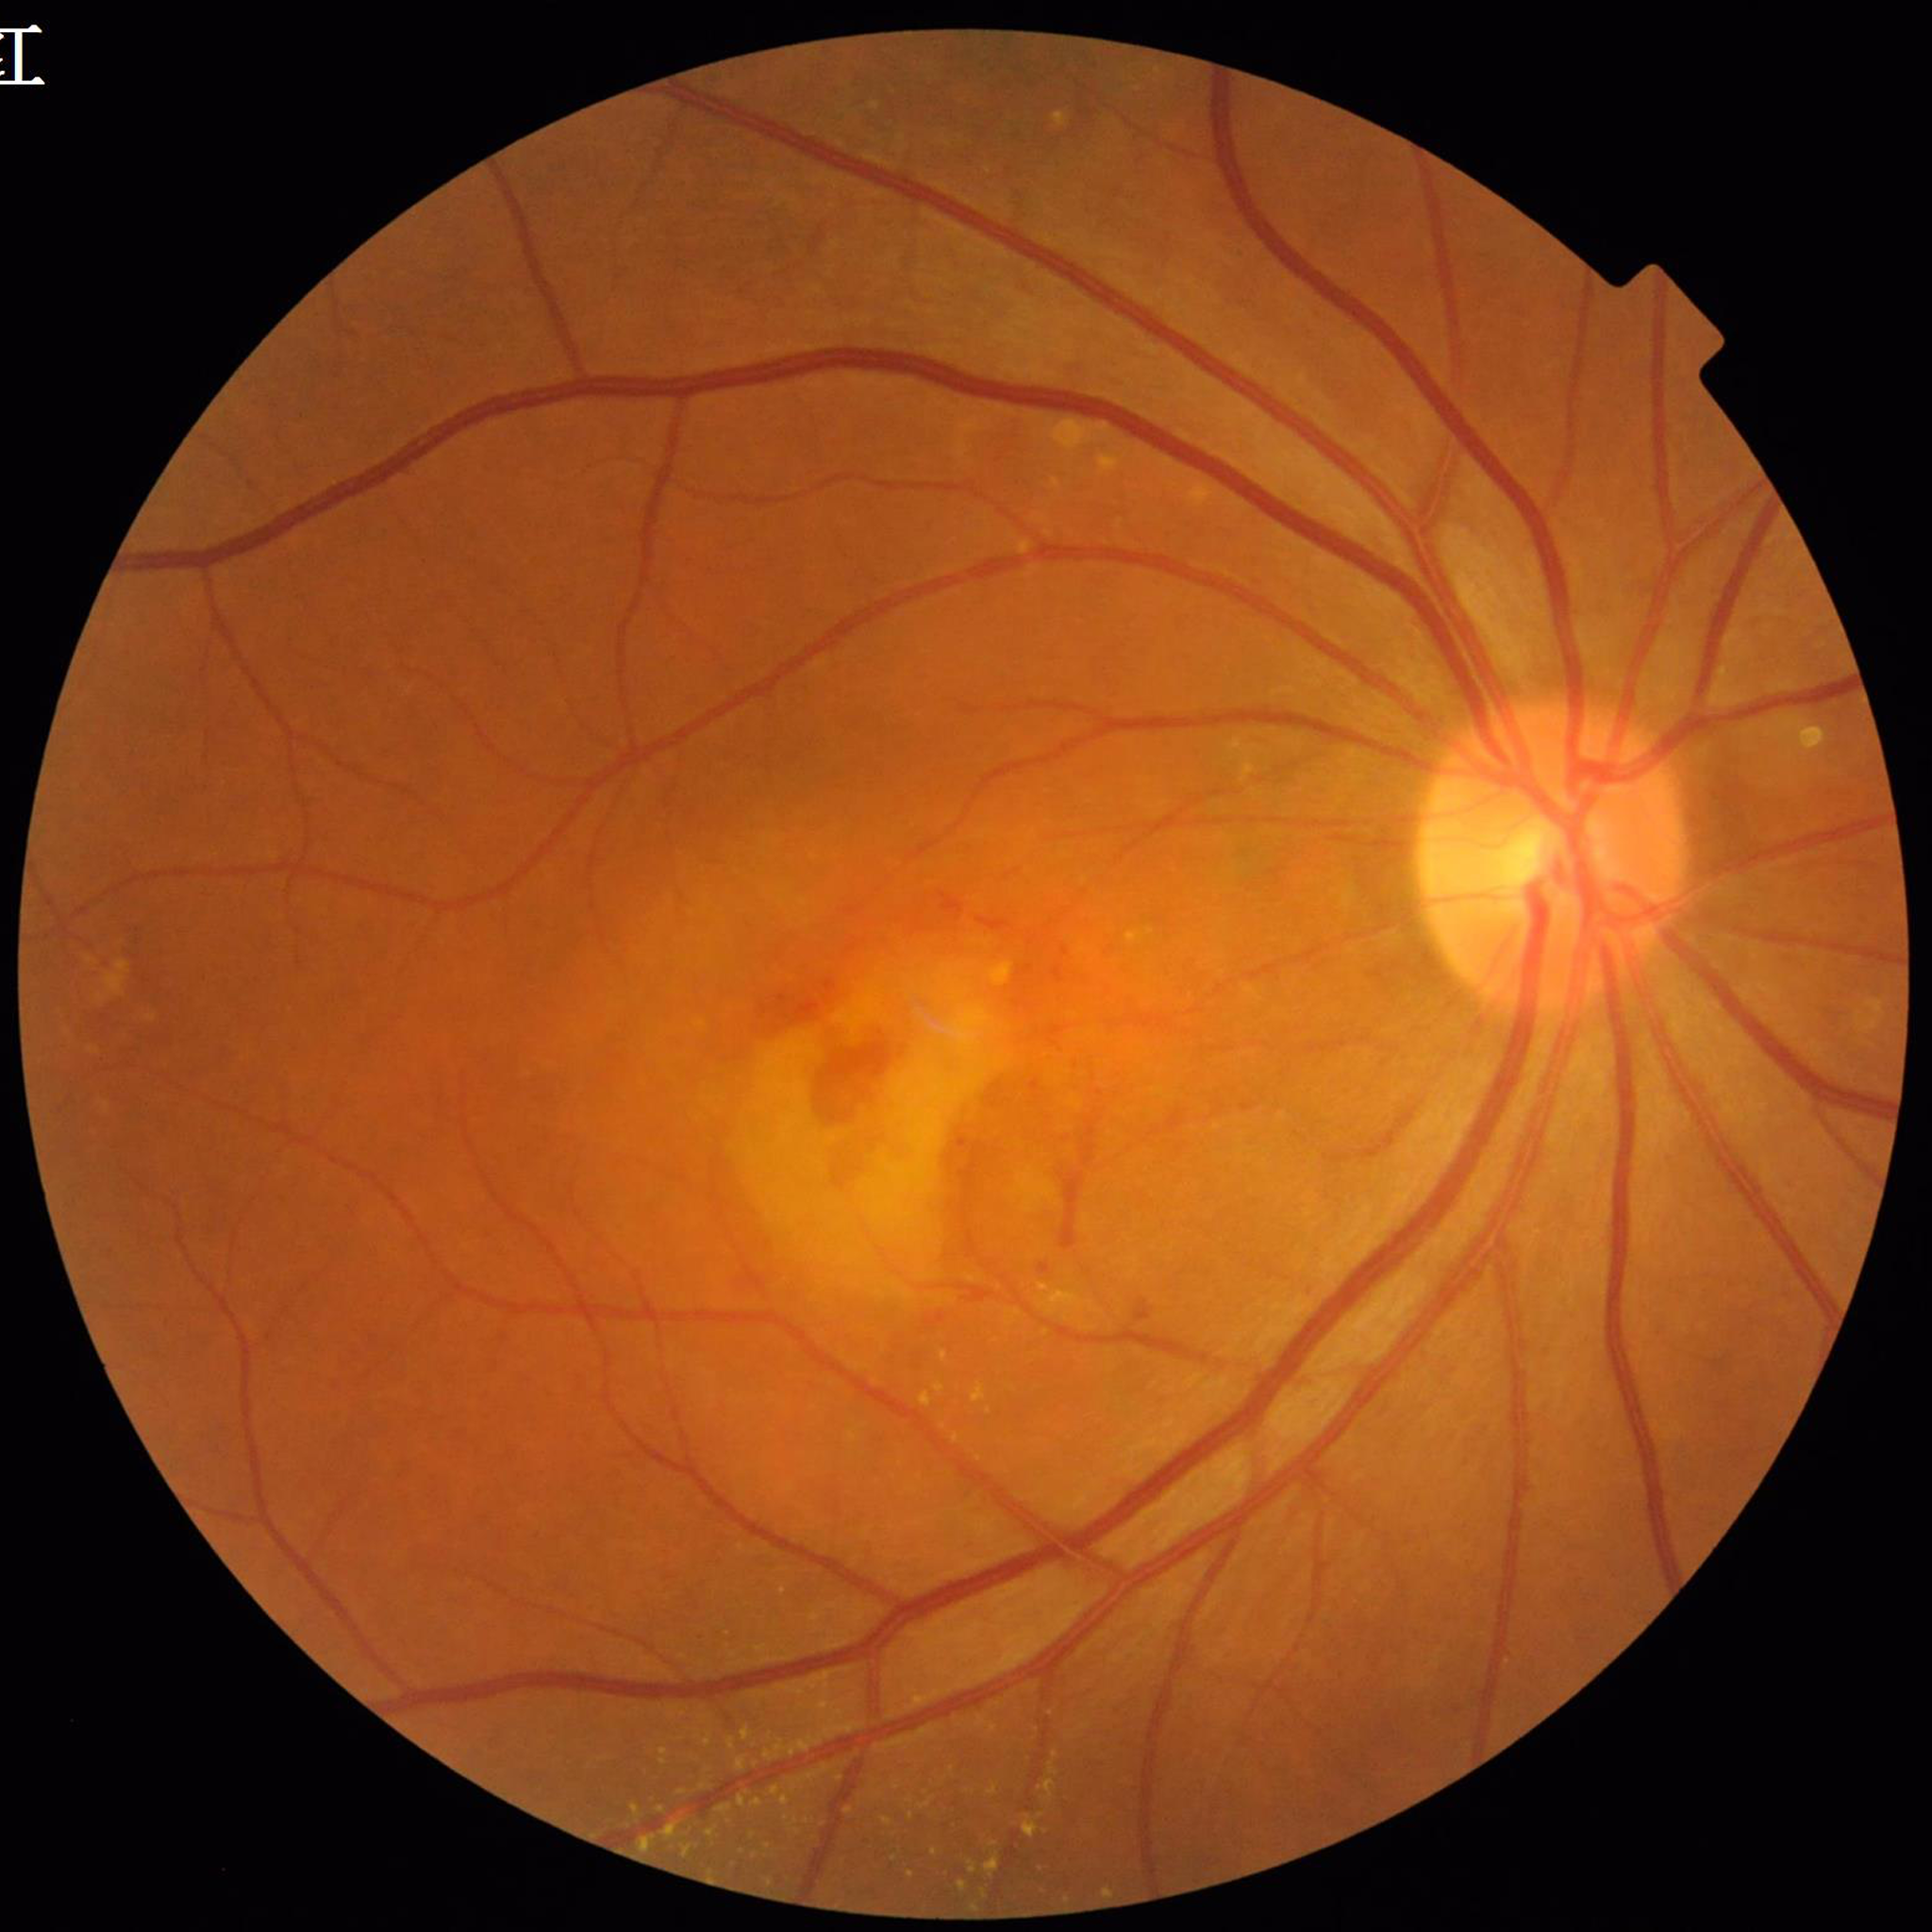

Impression = age-related macular degeneration (AMD).